Modified Davis grading · 848x848px — 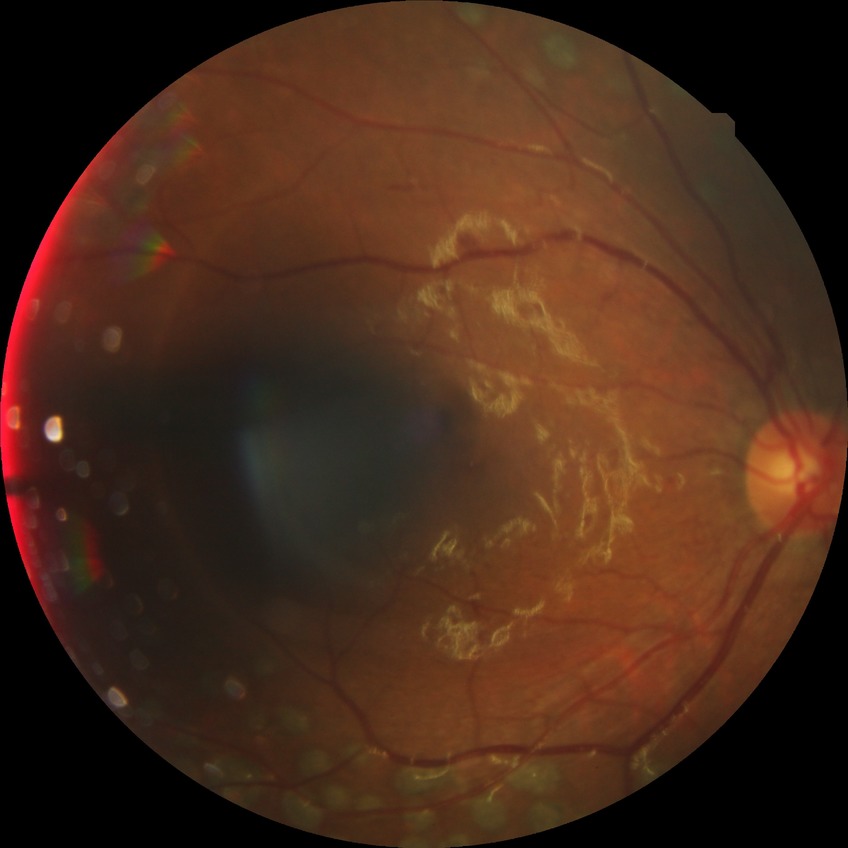

DR grade: PDR.